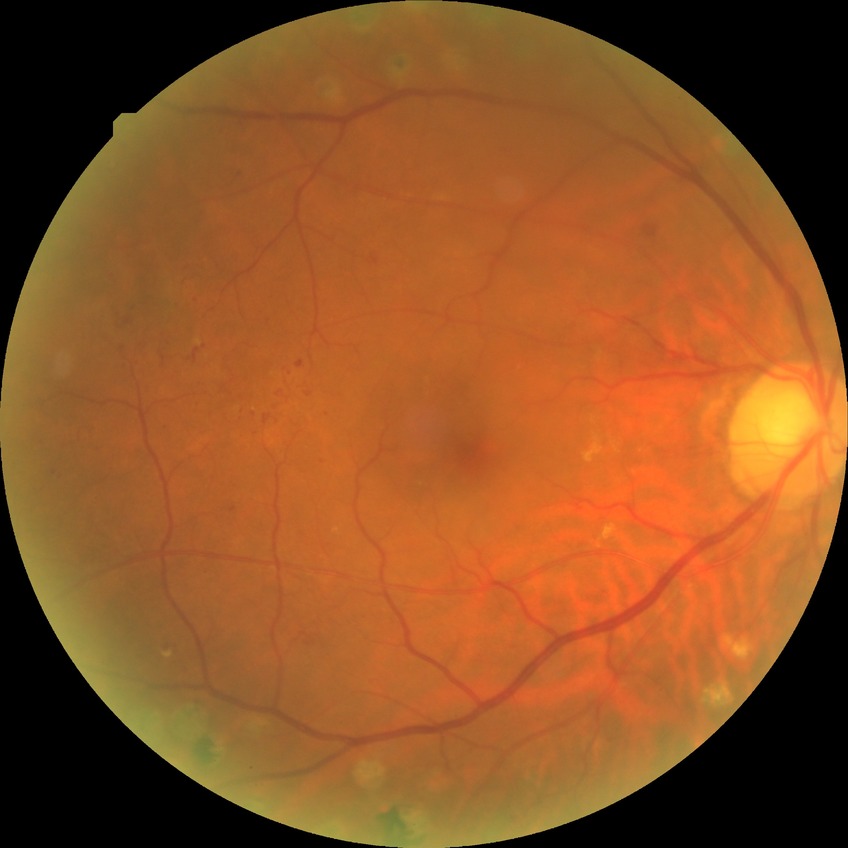 Diabetic retinopathy (DR) is PDR (proliferative diabetic retinopathy).